Without pupil dilation. NIDEK AFC-230 fundus camera. Image size 848x848: 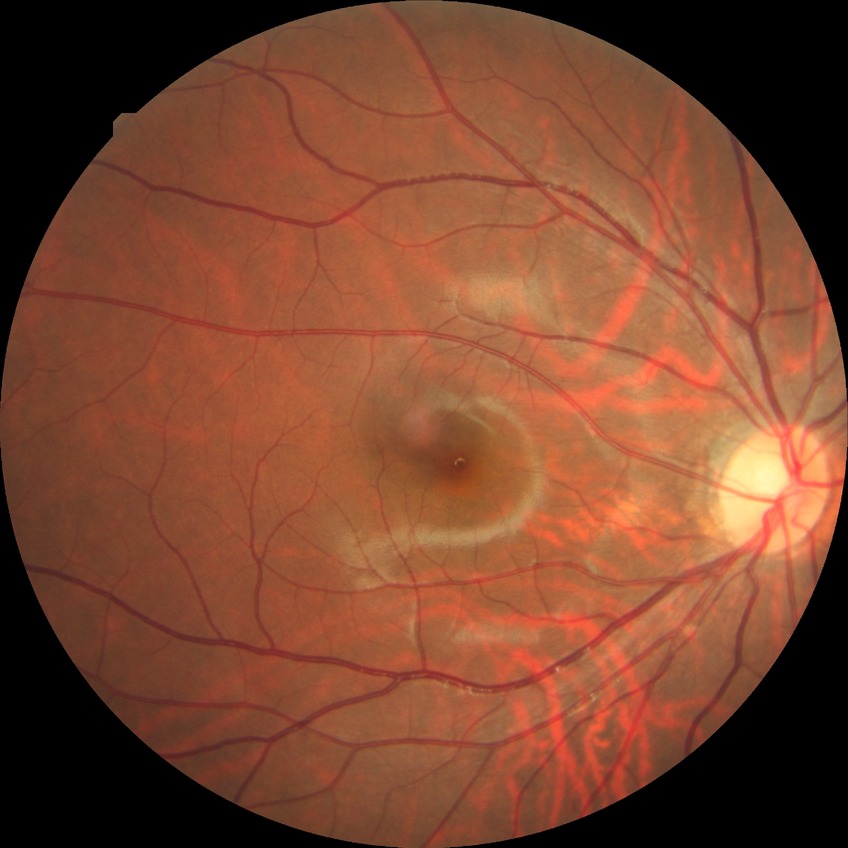

diabetic retinopathy (DR)@simple diabetic retinopathy (SDR).